Nonmydriatic fundus photograph, camera: NIDEK AFC-230
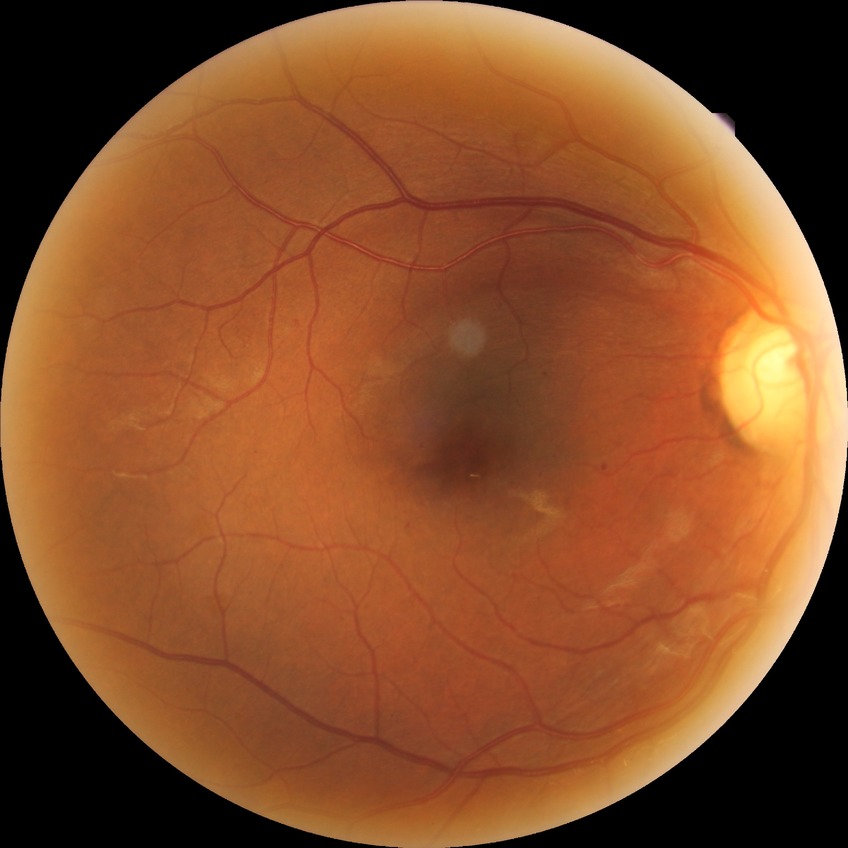
Modified Davis classification: simple diabetic retinopathy.